Color fundus photograph:
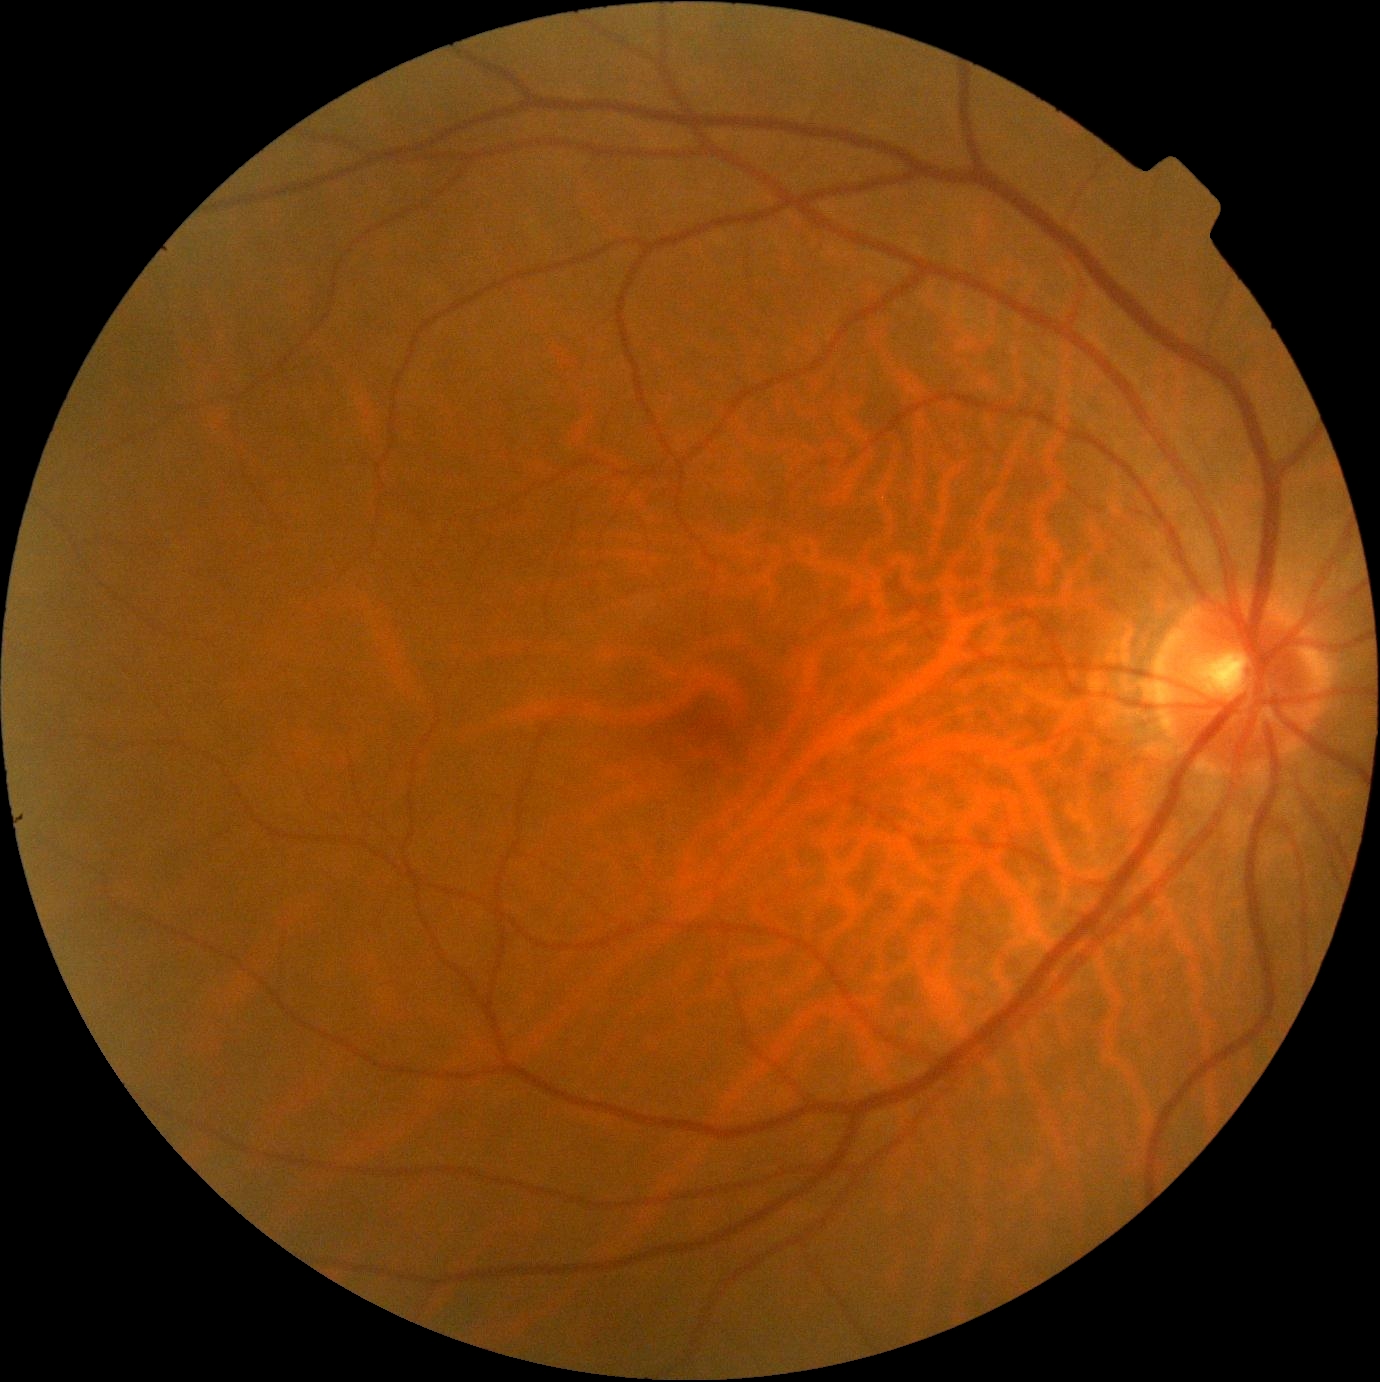
No diabetic retinal disease findings.
Retinopathy: 0/4.